Infant wide-field retinal image. Image size 640x480
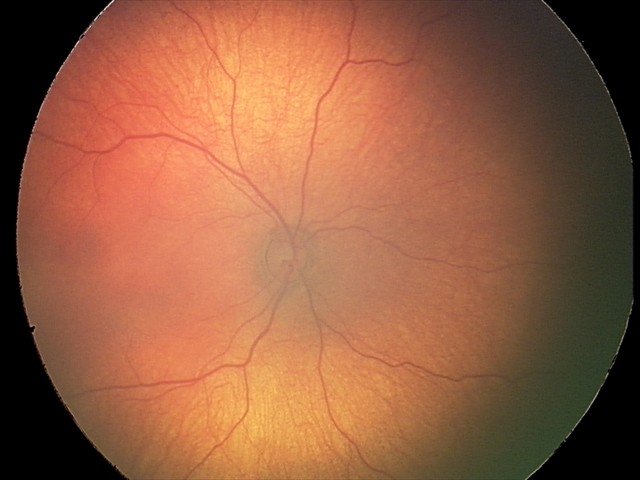 Diagnosis: normal